412x310. Color fundus image — 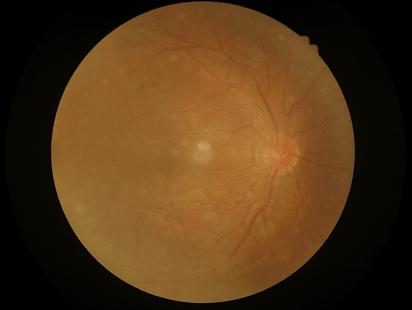 Vessels and details are hard to distinguish. Reduced sharpness with visible blur. Image quality is suboptimal. No over- or under-exposure.